Topcon TRC-50DX
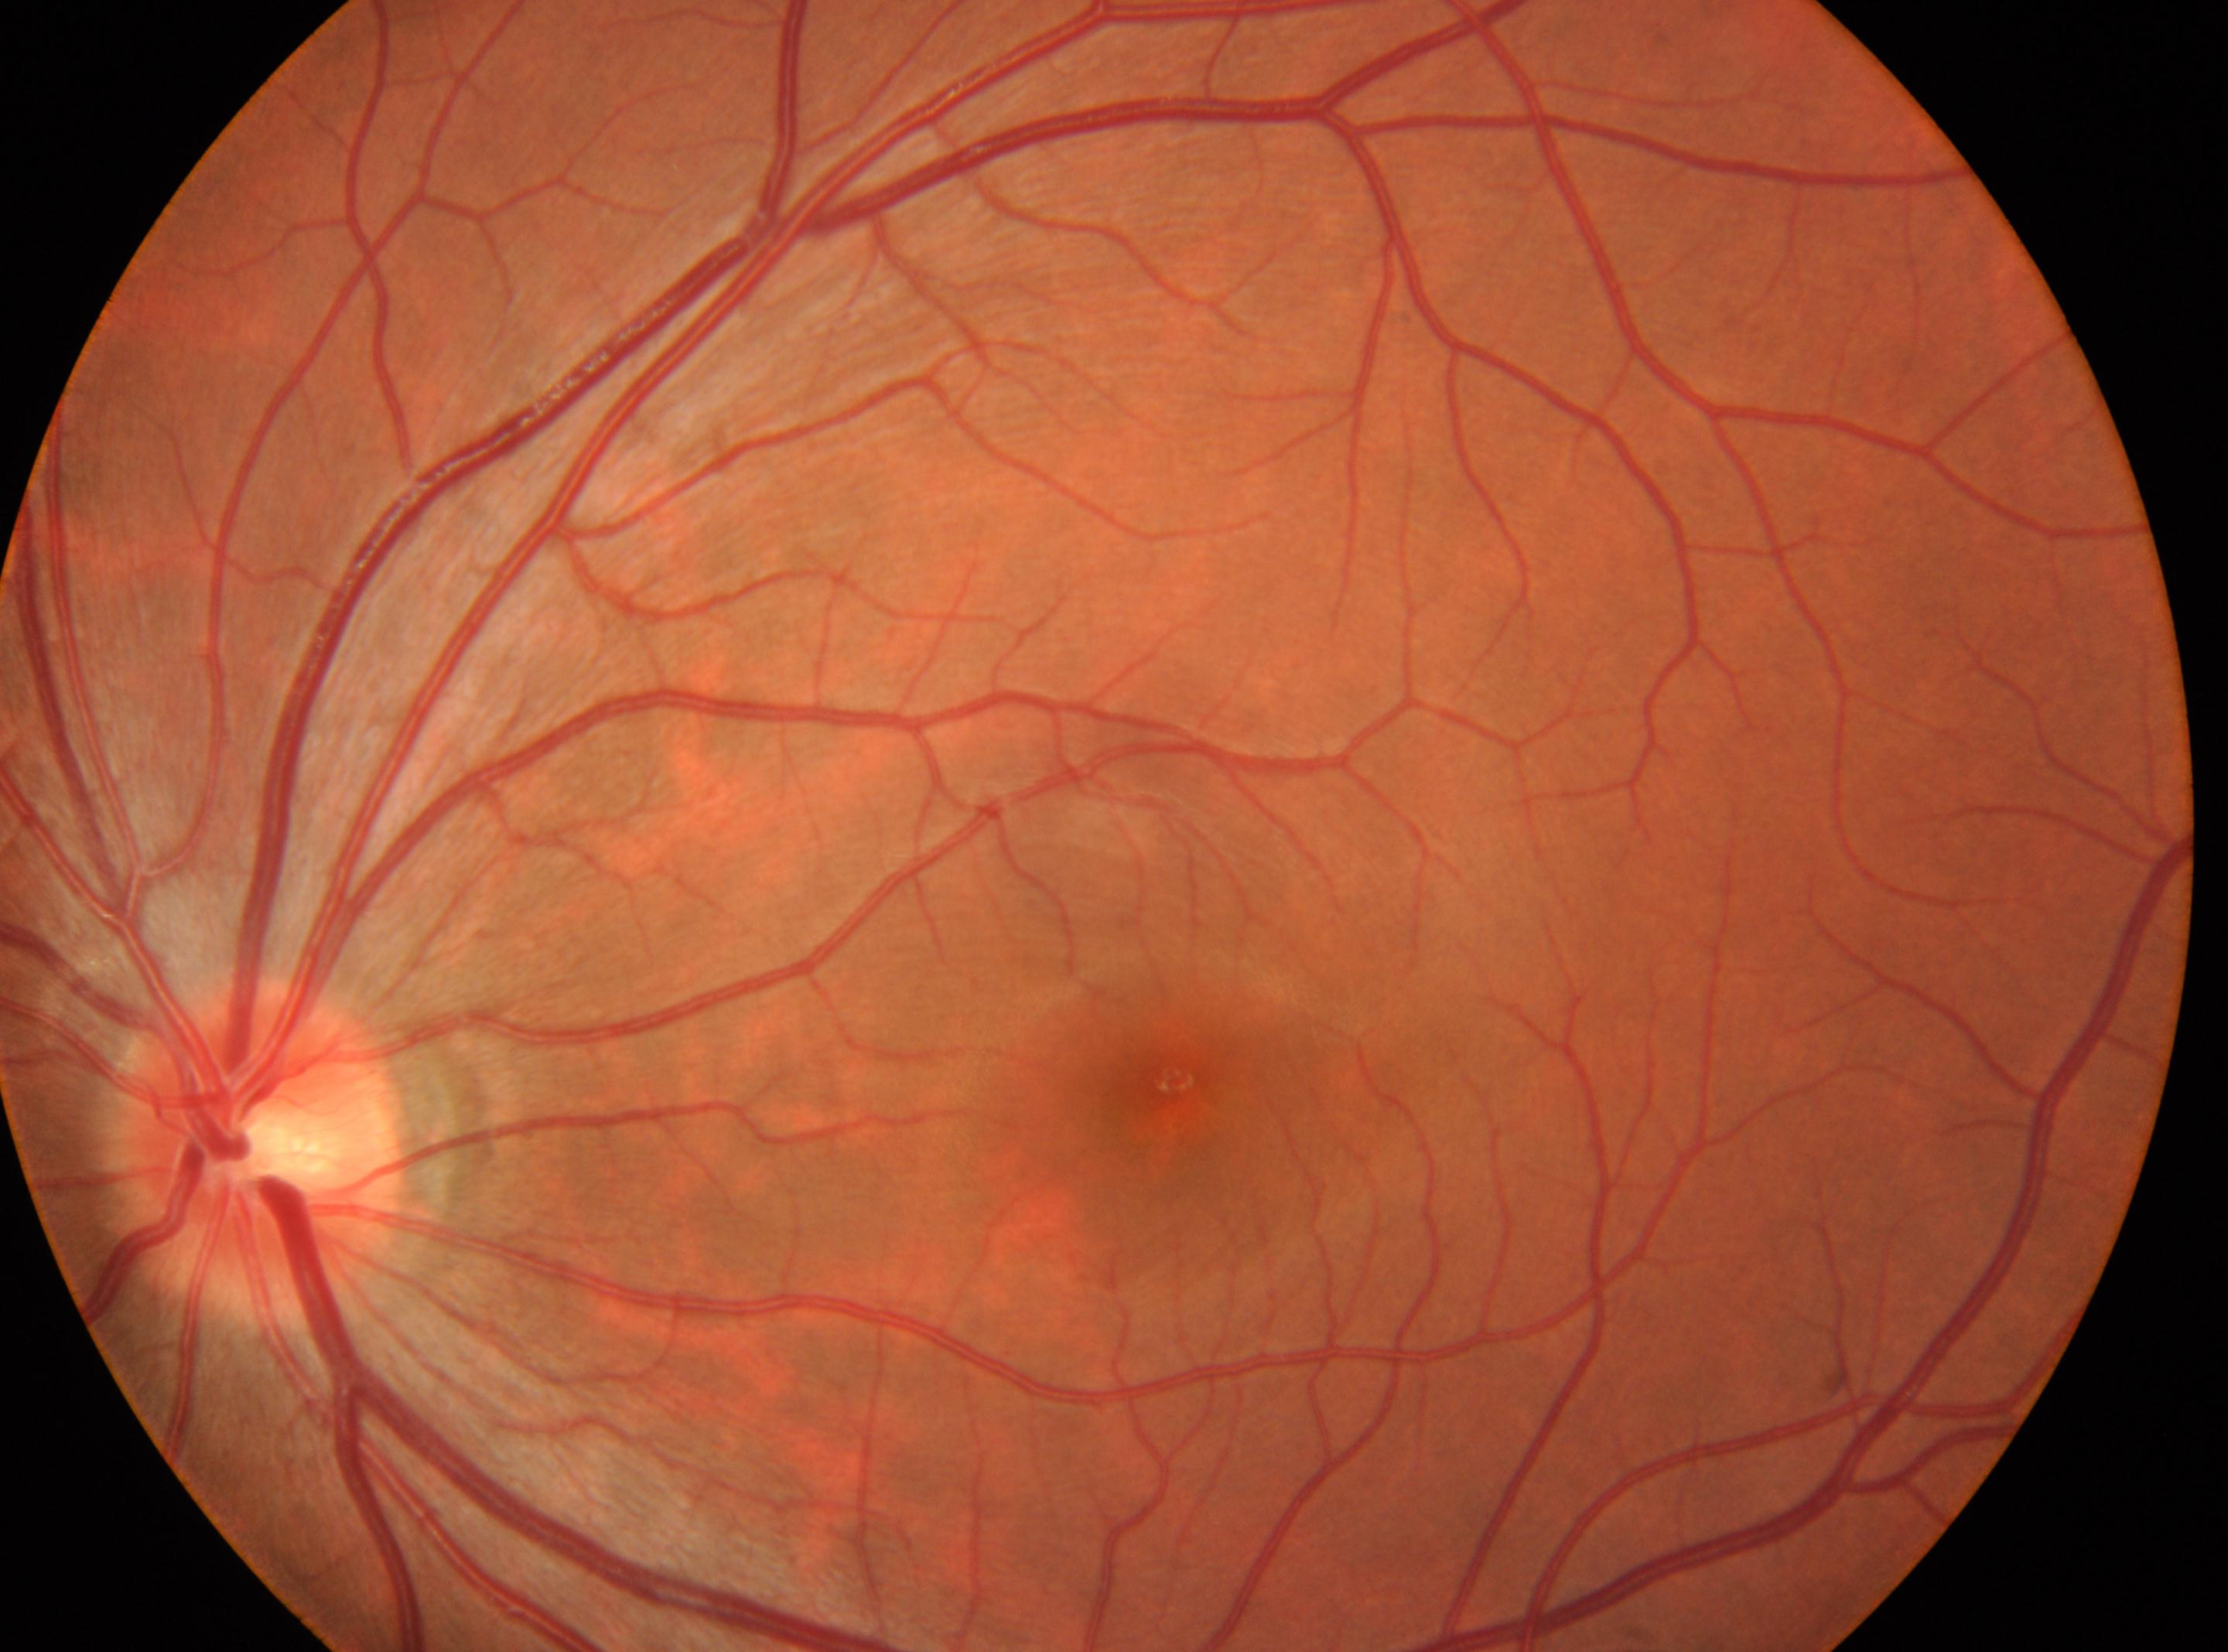 This is the oculus sinister. The optic disk is at (257, 1151). DR severity is grade 0 (no apparent retinopathy) — no visible signs of diabetic retinopathy. Macular center located at (1173, 1081).